848x848; fundus photo; acquired with a NIDEK AFC-230
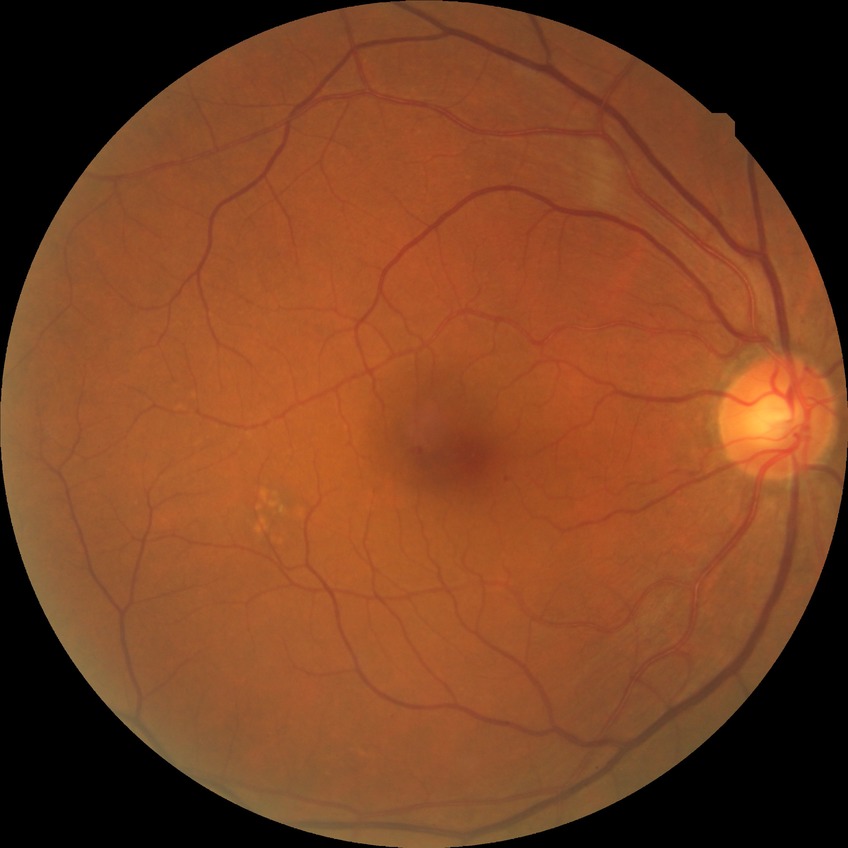   davis_grade: simple diabetic retinopathy
  proliferative_class: non-proliferative diabetic retinopathy